Optic disc region of a color fundus photo, Topcon TRC fundus camera, 352 by 352 pixels
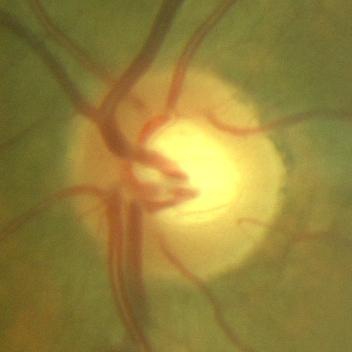

There is evidence of no glaucomatous damage.